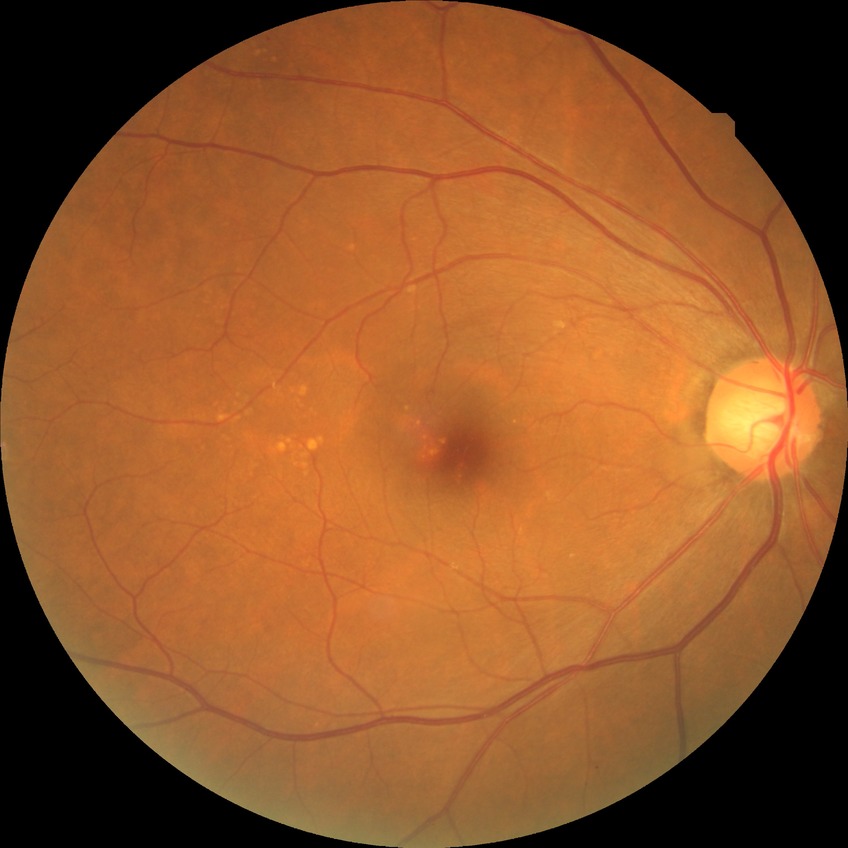 Retinopathy stage: no diabetic retinopathy.